Acquired on the Clarity RetCam 3; wide-field contact fundus photograph of an infant: 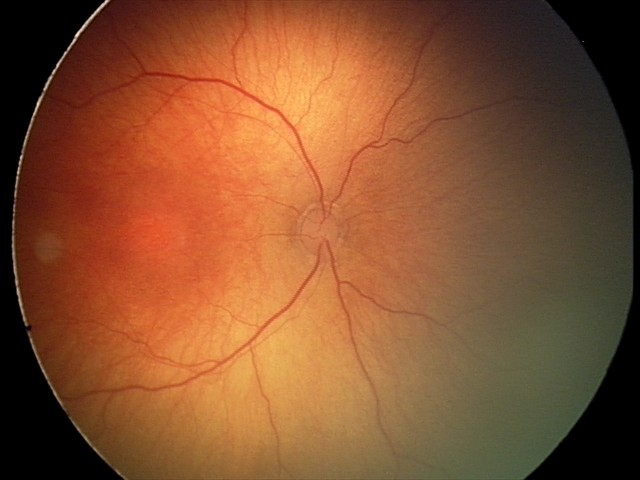

Screening diagnosis: ROP stage 2.